Posterior pole color fundus photograph.
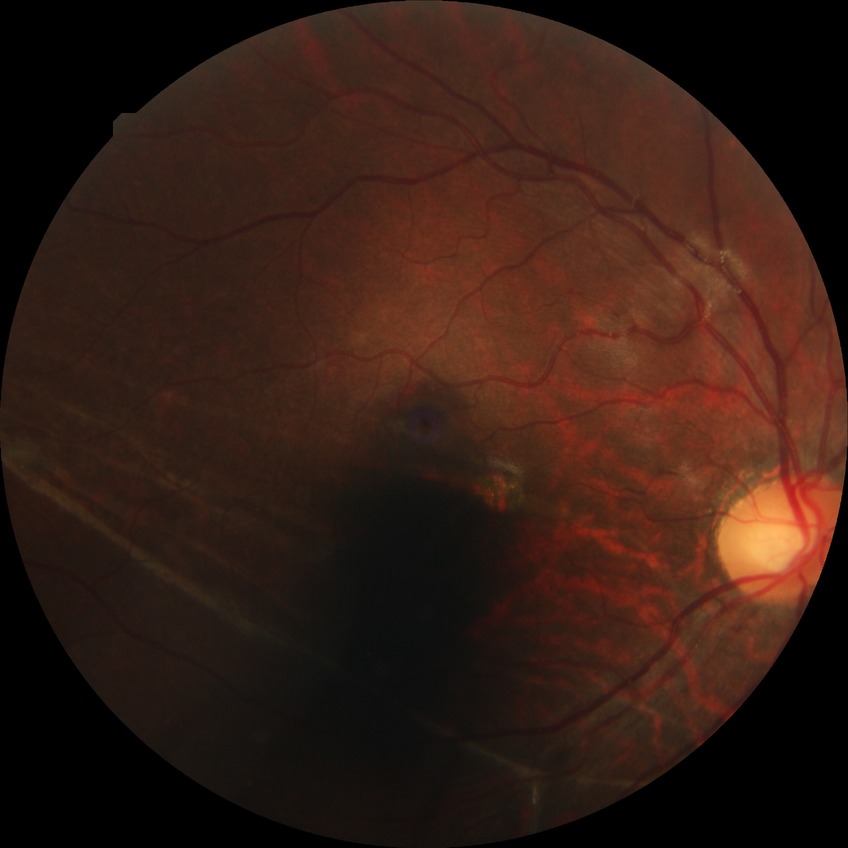 Diabetic retinopathy (DR) is NDR (no diabetic retinopathy).